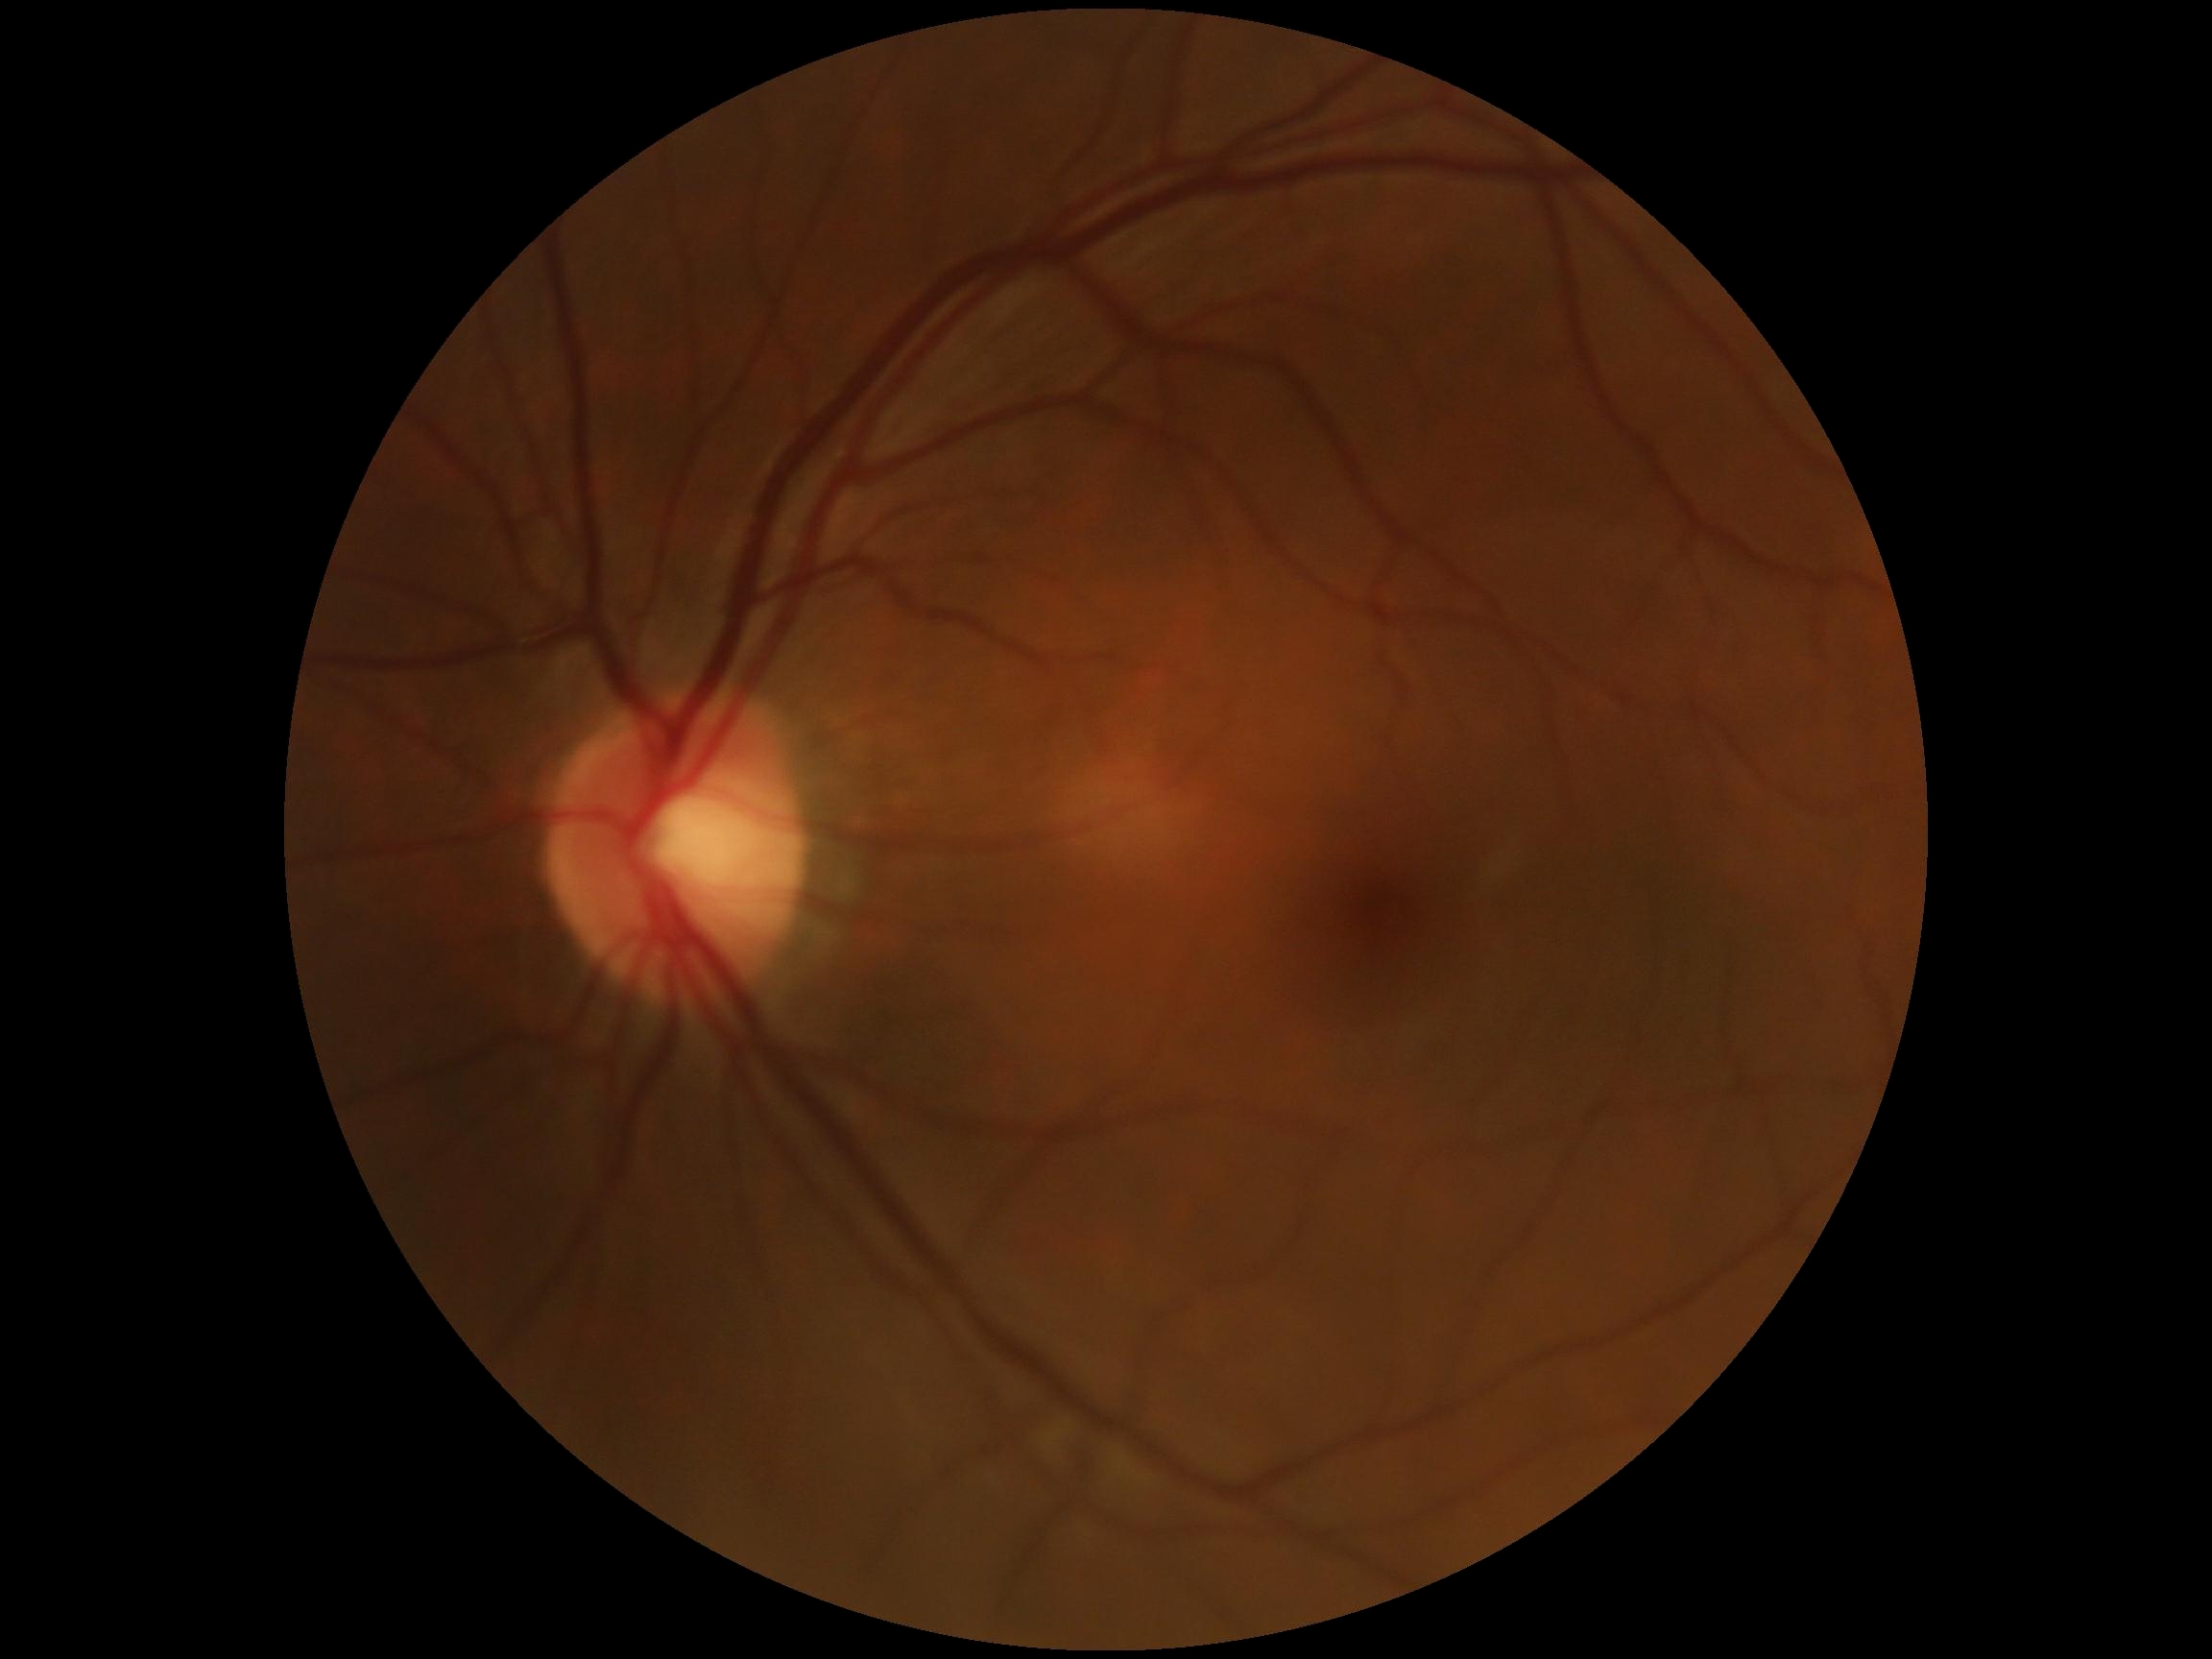
Retinopathy is grade 0 (no apparent retinopathy).